Disc-centered field. Image size 240x240
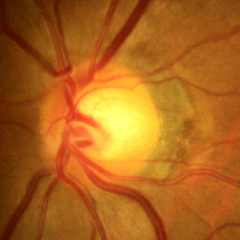

Glaucoma status = no glaucoma.